1240 by 1240 pixels. Wide-field fundus photograph from neonatal ROP screening
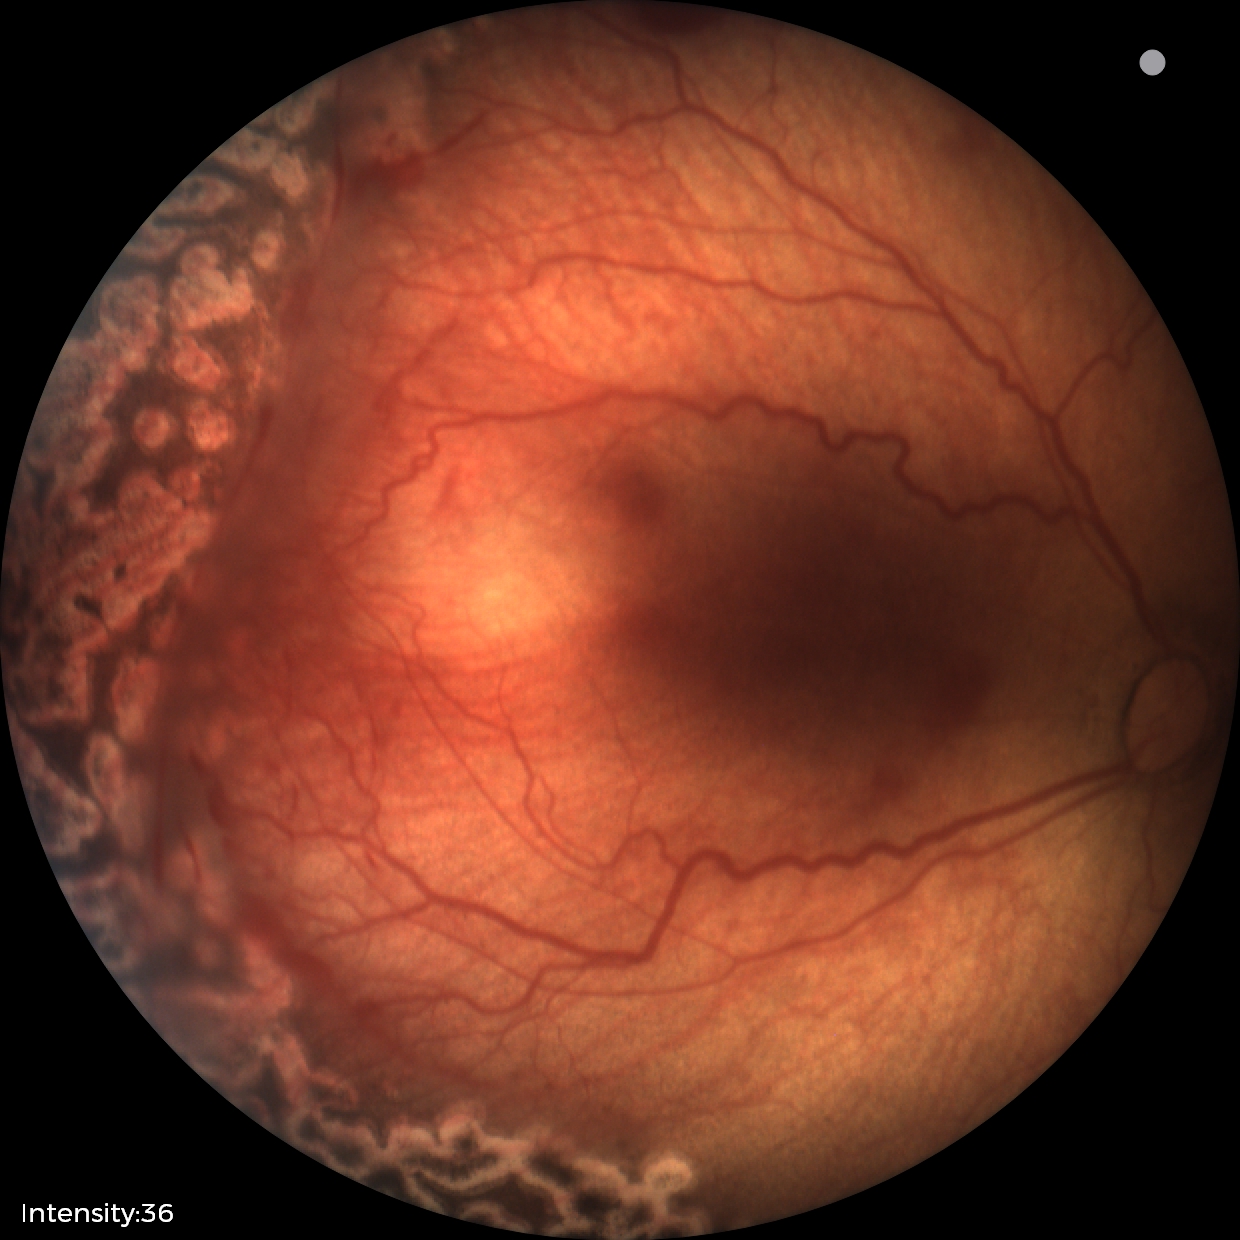
Impression: status post retinopathy of prematurity | no plus disease.